640x480px. Acquired on the Clarity RetCam 3. RetCam wide-field infant fundus image: 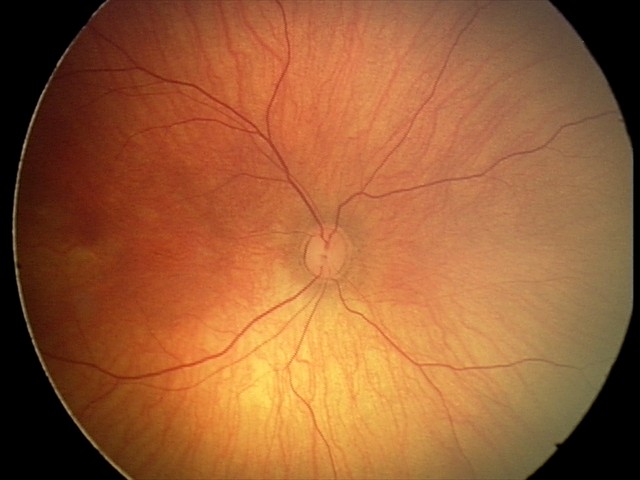 Impression = normal